No pharmacologic dilation, DR severity per modified Davis staging — 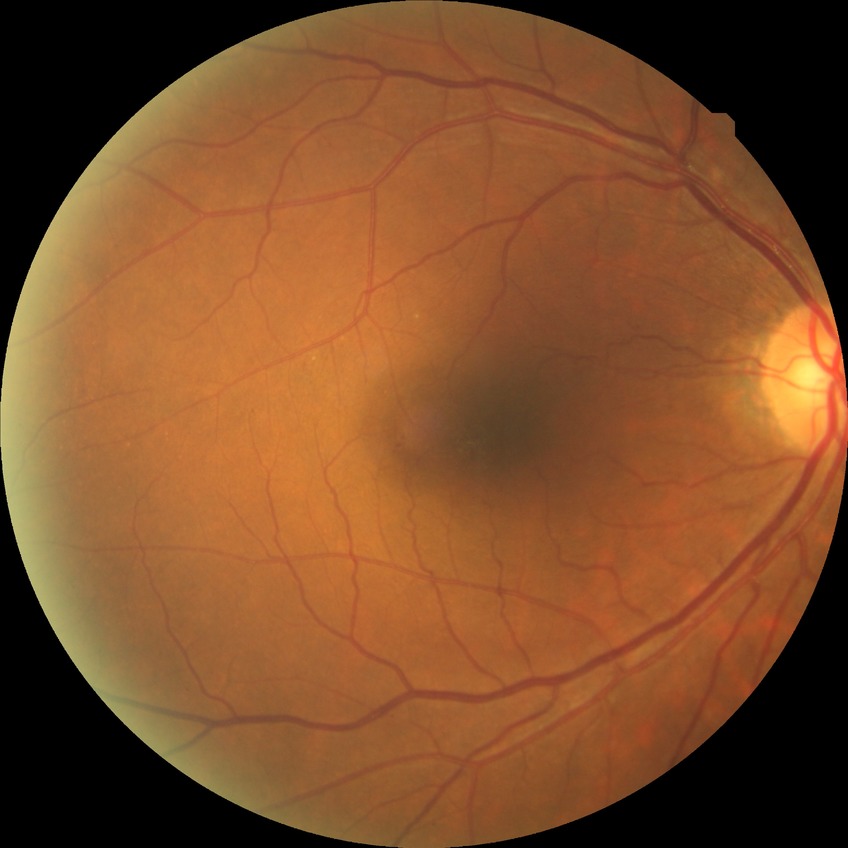

Diabetic retinopathy grade is no diabetic retinopathy.